412 x 310 pixels, CFP
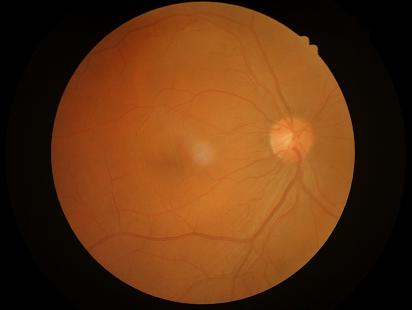

  clarity: out of focus, structures indistinct
  overall_quality: poor and difficult to use diagnostically
  contrast: good dynamic range